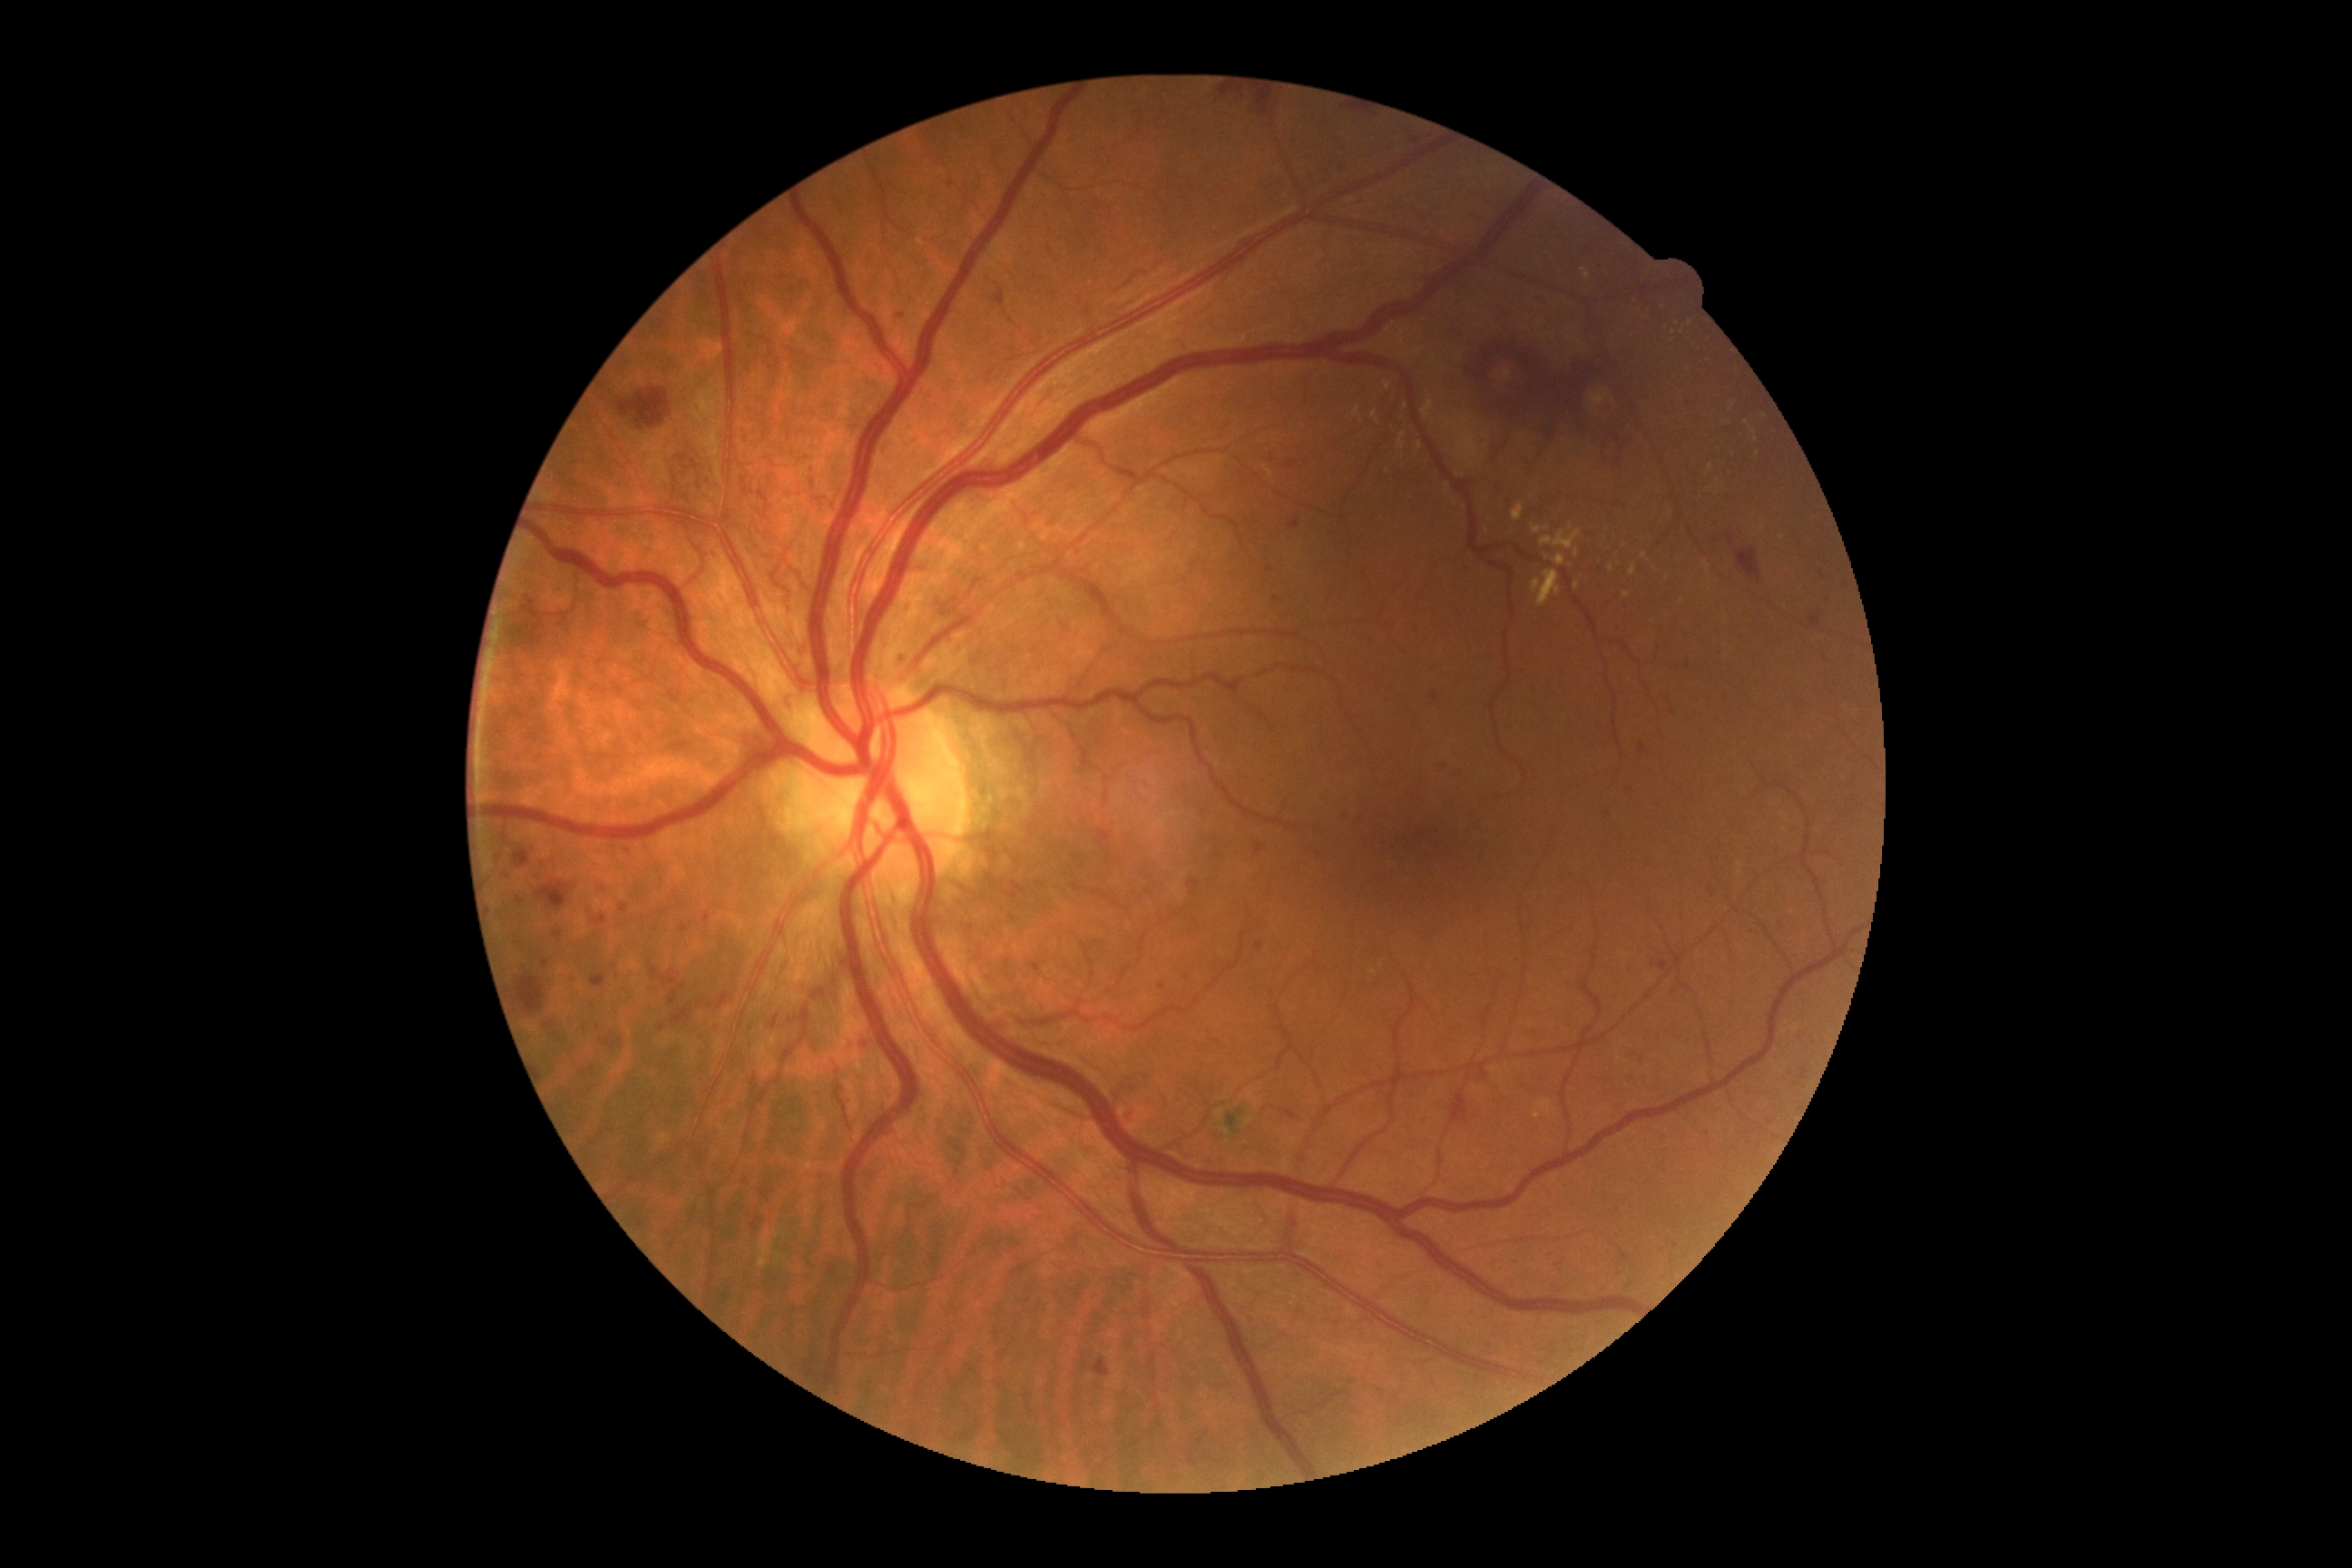
Retinopathy grade: 3
Representative lesions:
* microaneurysms (partial): (691,460,698,469); (1349,199,1362,204); (1534,293,1547,304); (676,455,689,464); (620,905,629,914); (995,291,1006,308); (1640,745,1647,754); (571,977,574,985); (1625,1075,1634,1081)
* Small microaneurysms approximately at <point>612, 1035</point>; <point>583, 1075</point>; <point>1643, 1061</point>; <point>1823, 578</point>; <point>1276, 599</point>; <point>546, 963</point>; <point>902, 659</point>; <point>1672, 710</point>; <point>1416, 141</point>